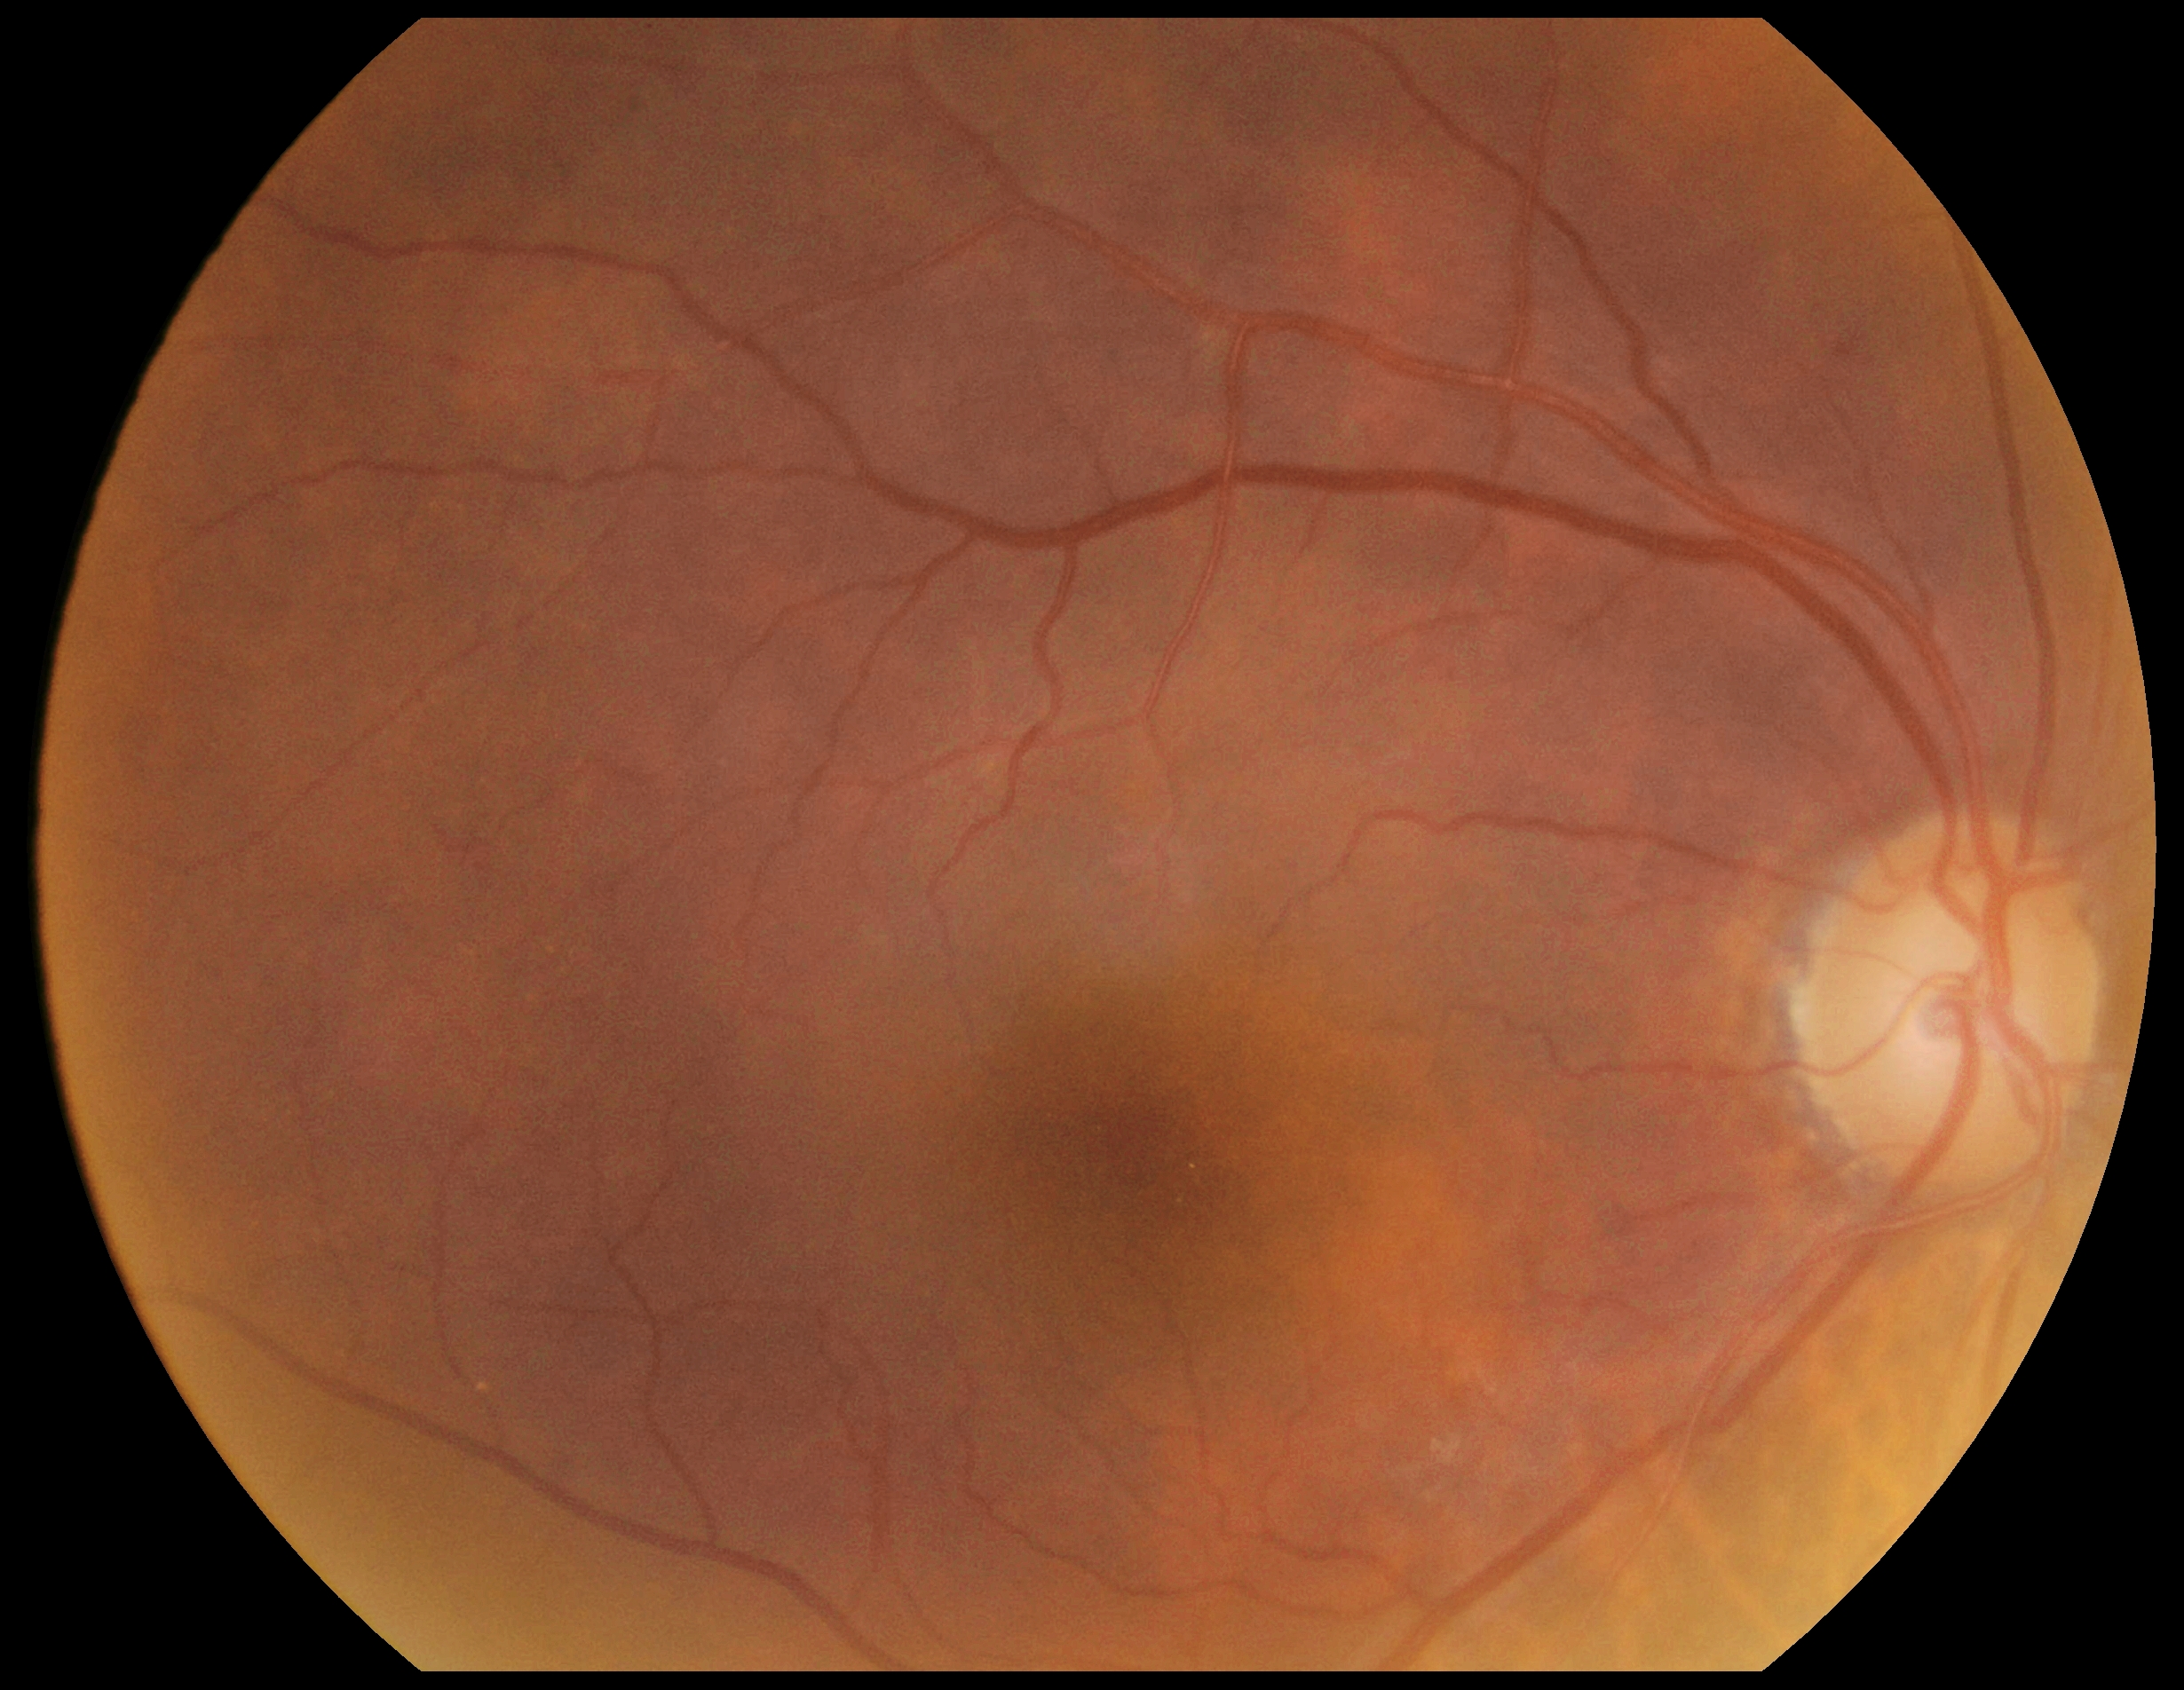
Diabetic retinopathy (DR): grade 0 — no visible signs of diabetic retinopathy.